Mydriatic (tropicamide and phenylephrine); retinal fundus photograph; 2228 by 1652 pixels; Topcon TRC-50DX; central posterior field: 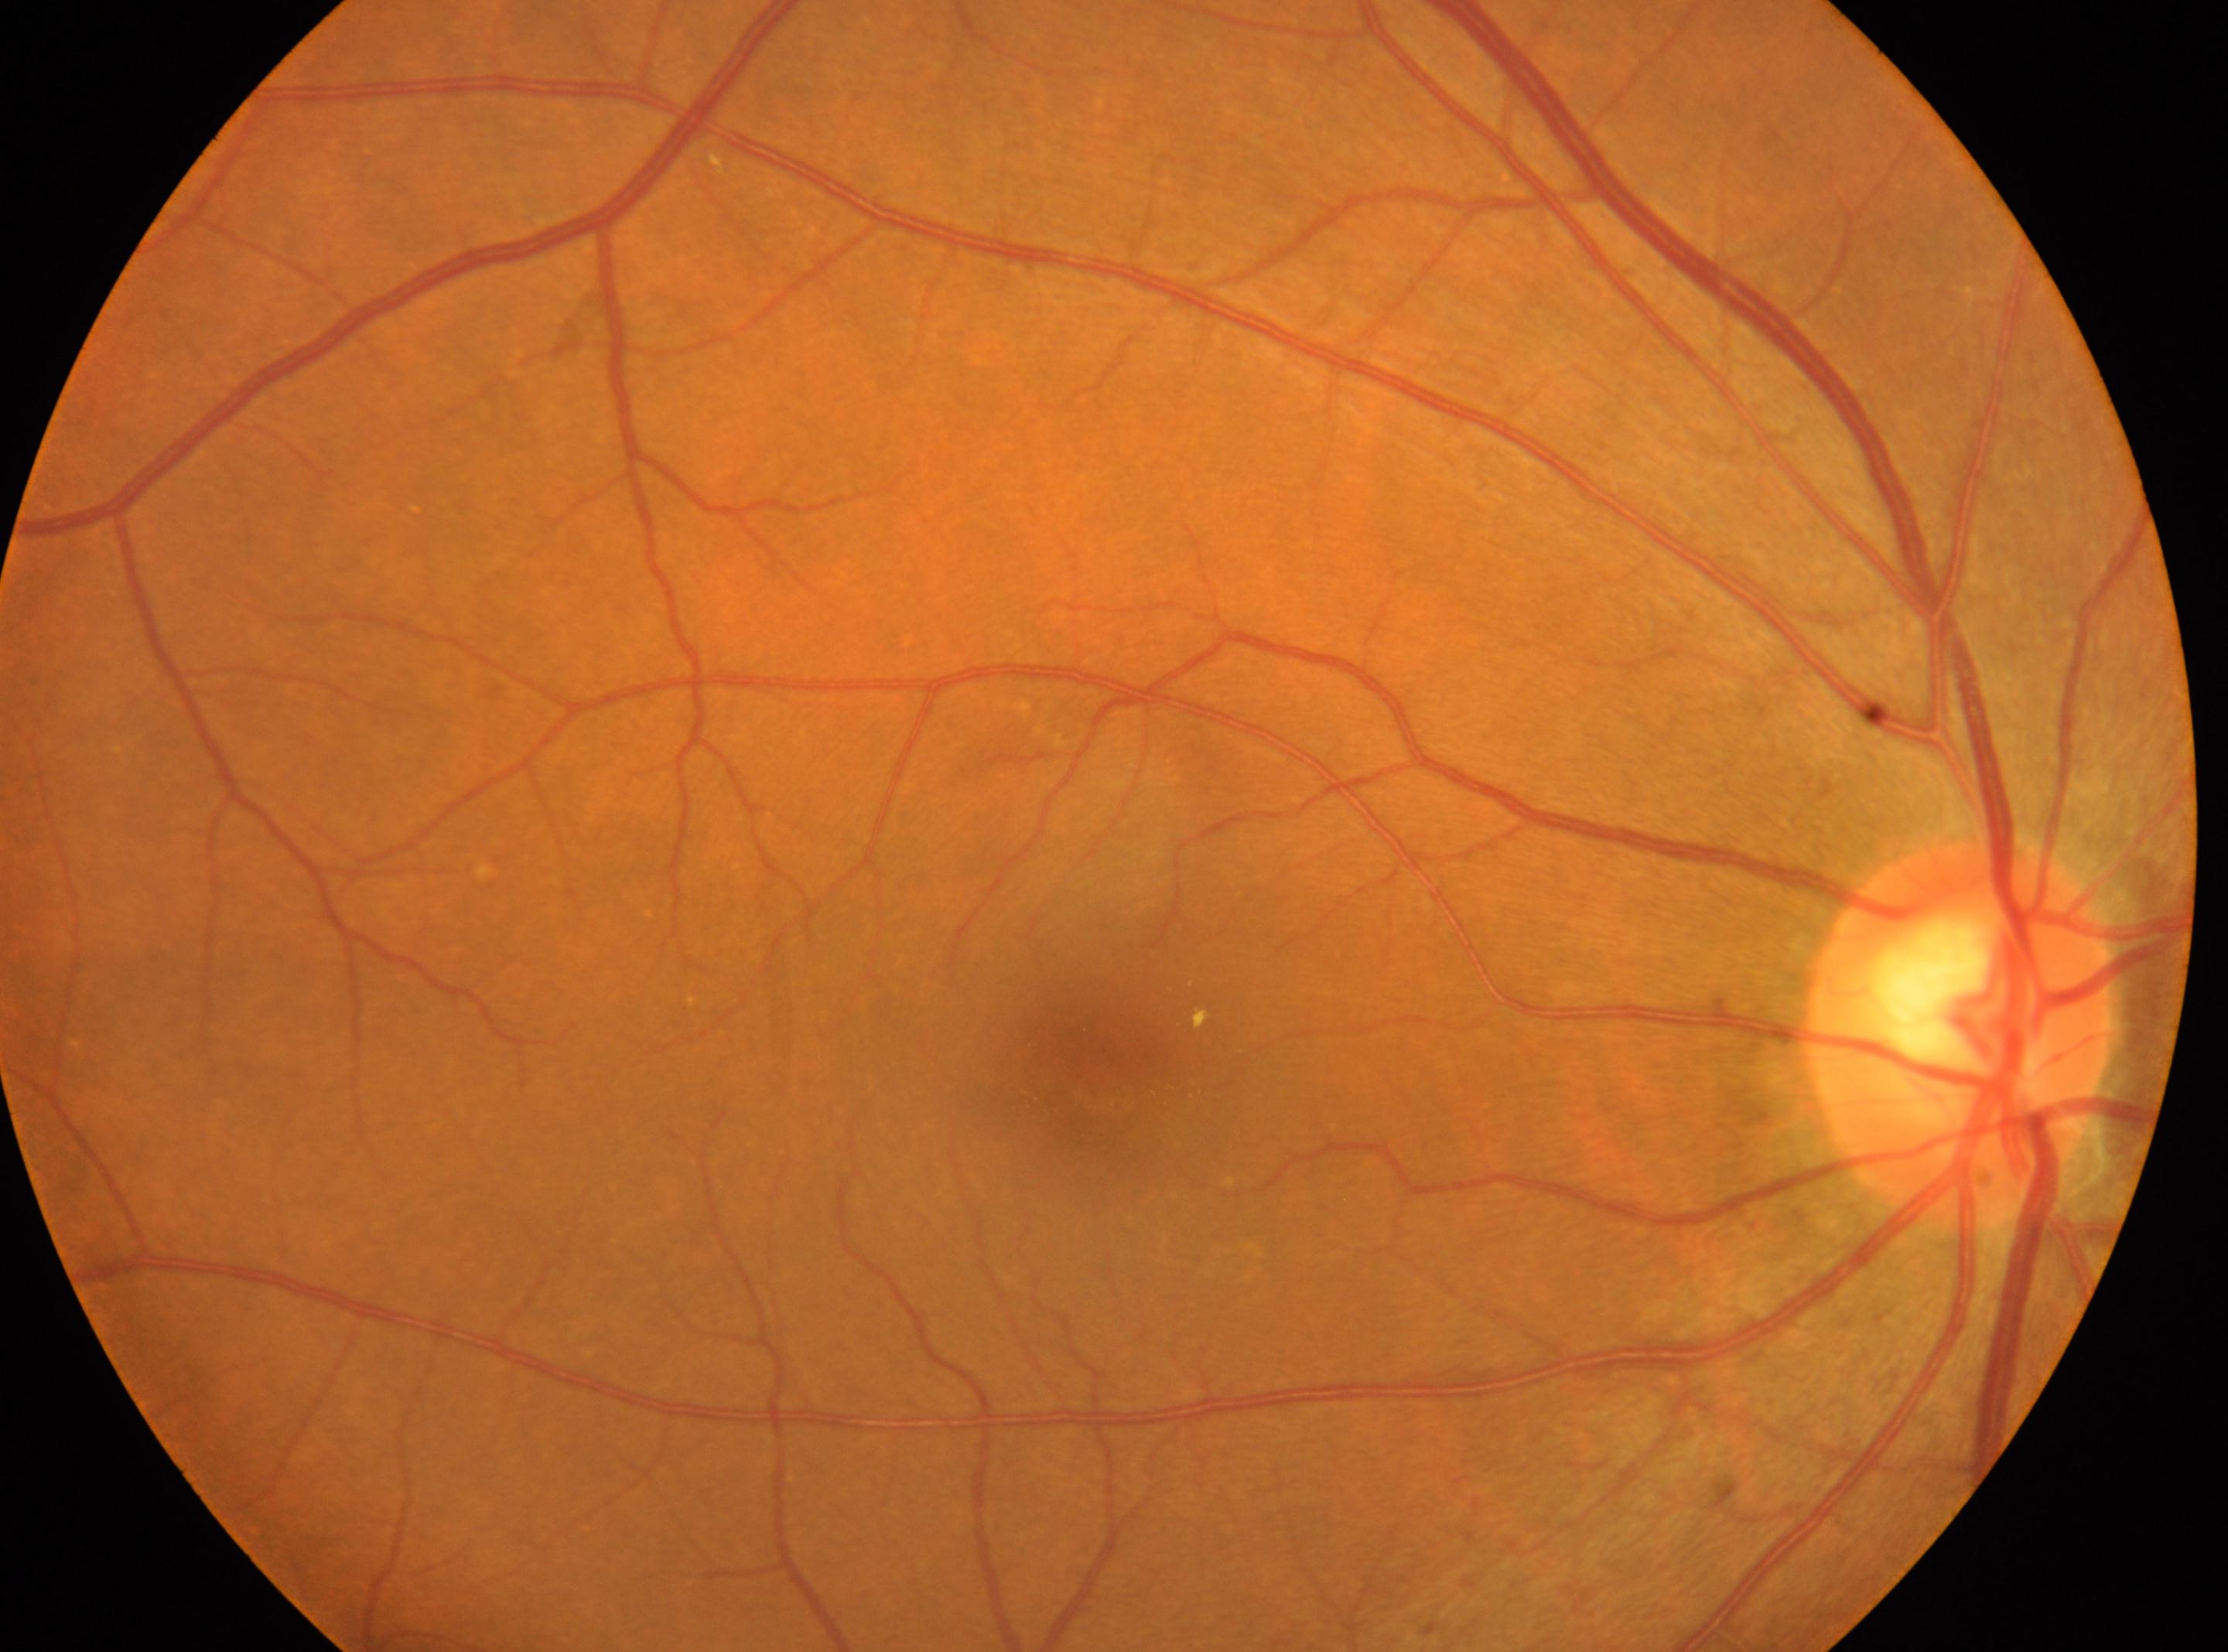
Disc center: 1960, 1029. The fovea is at 1100, 1080. Imaged eye: oculus dexter. Retinopathy grade: 2/4 — more than just microaneurysms but less than severe NPDR.